240 x 240 pixels.
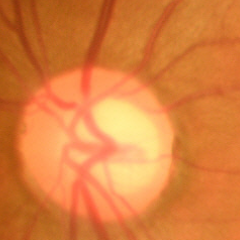 No glaucomatous changes.